Color fundus photograph:
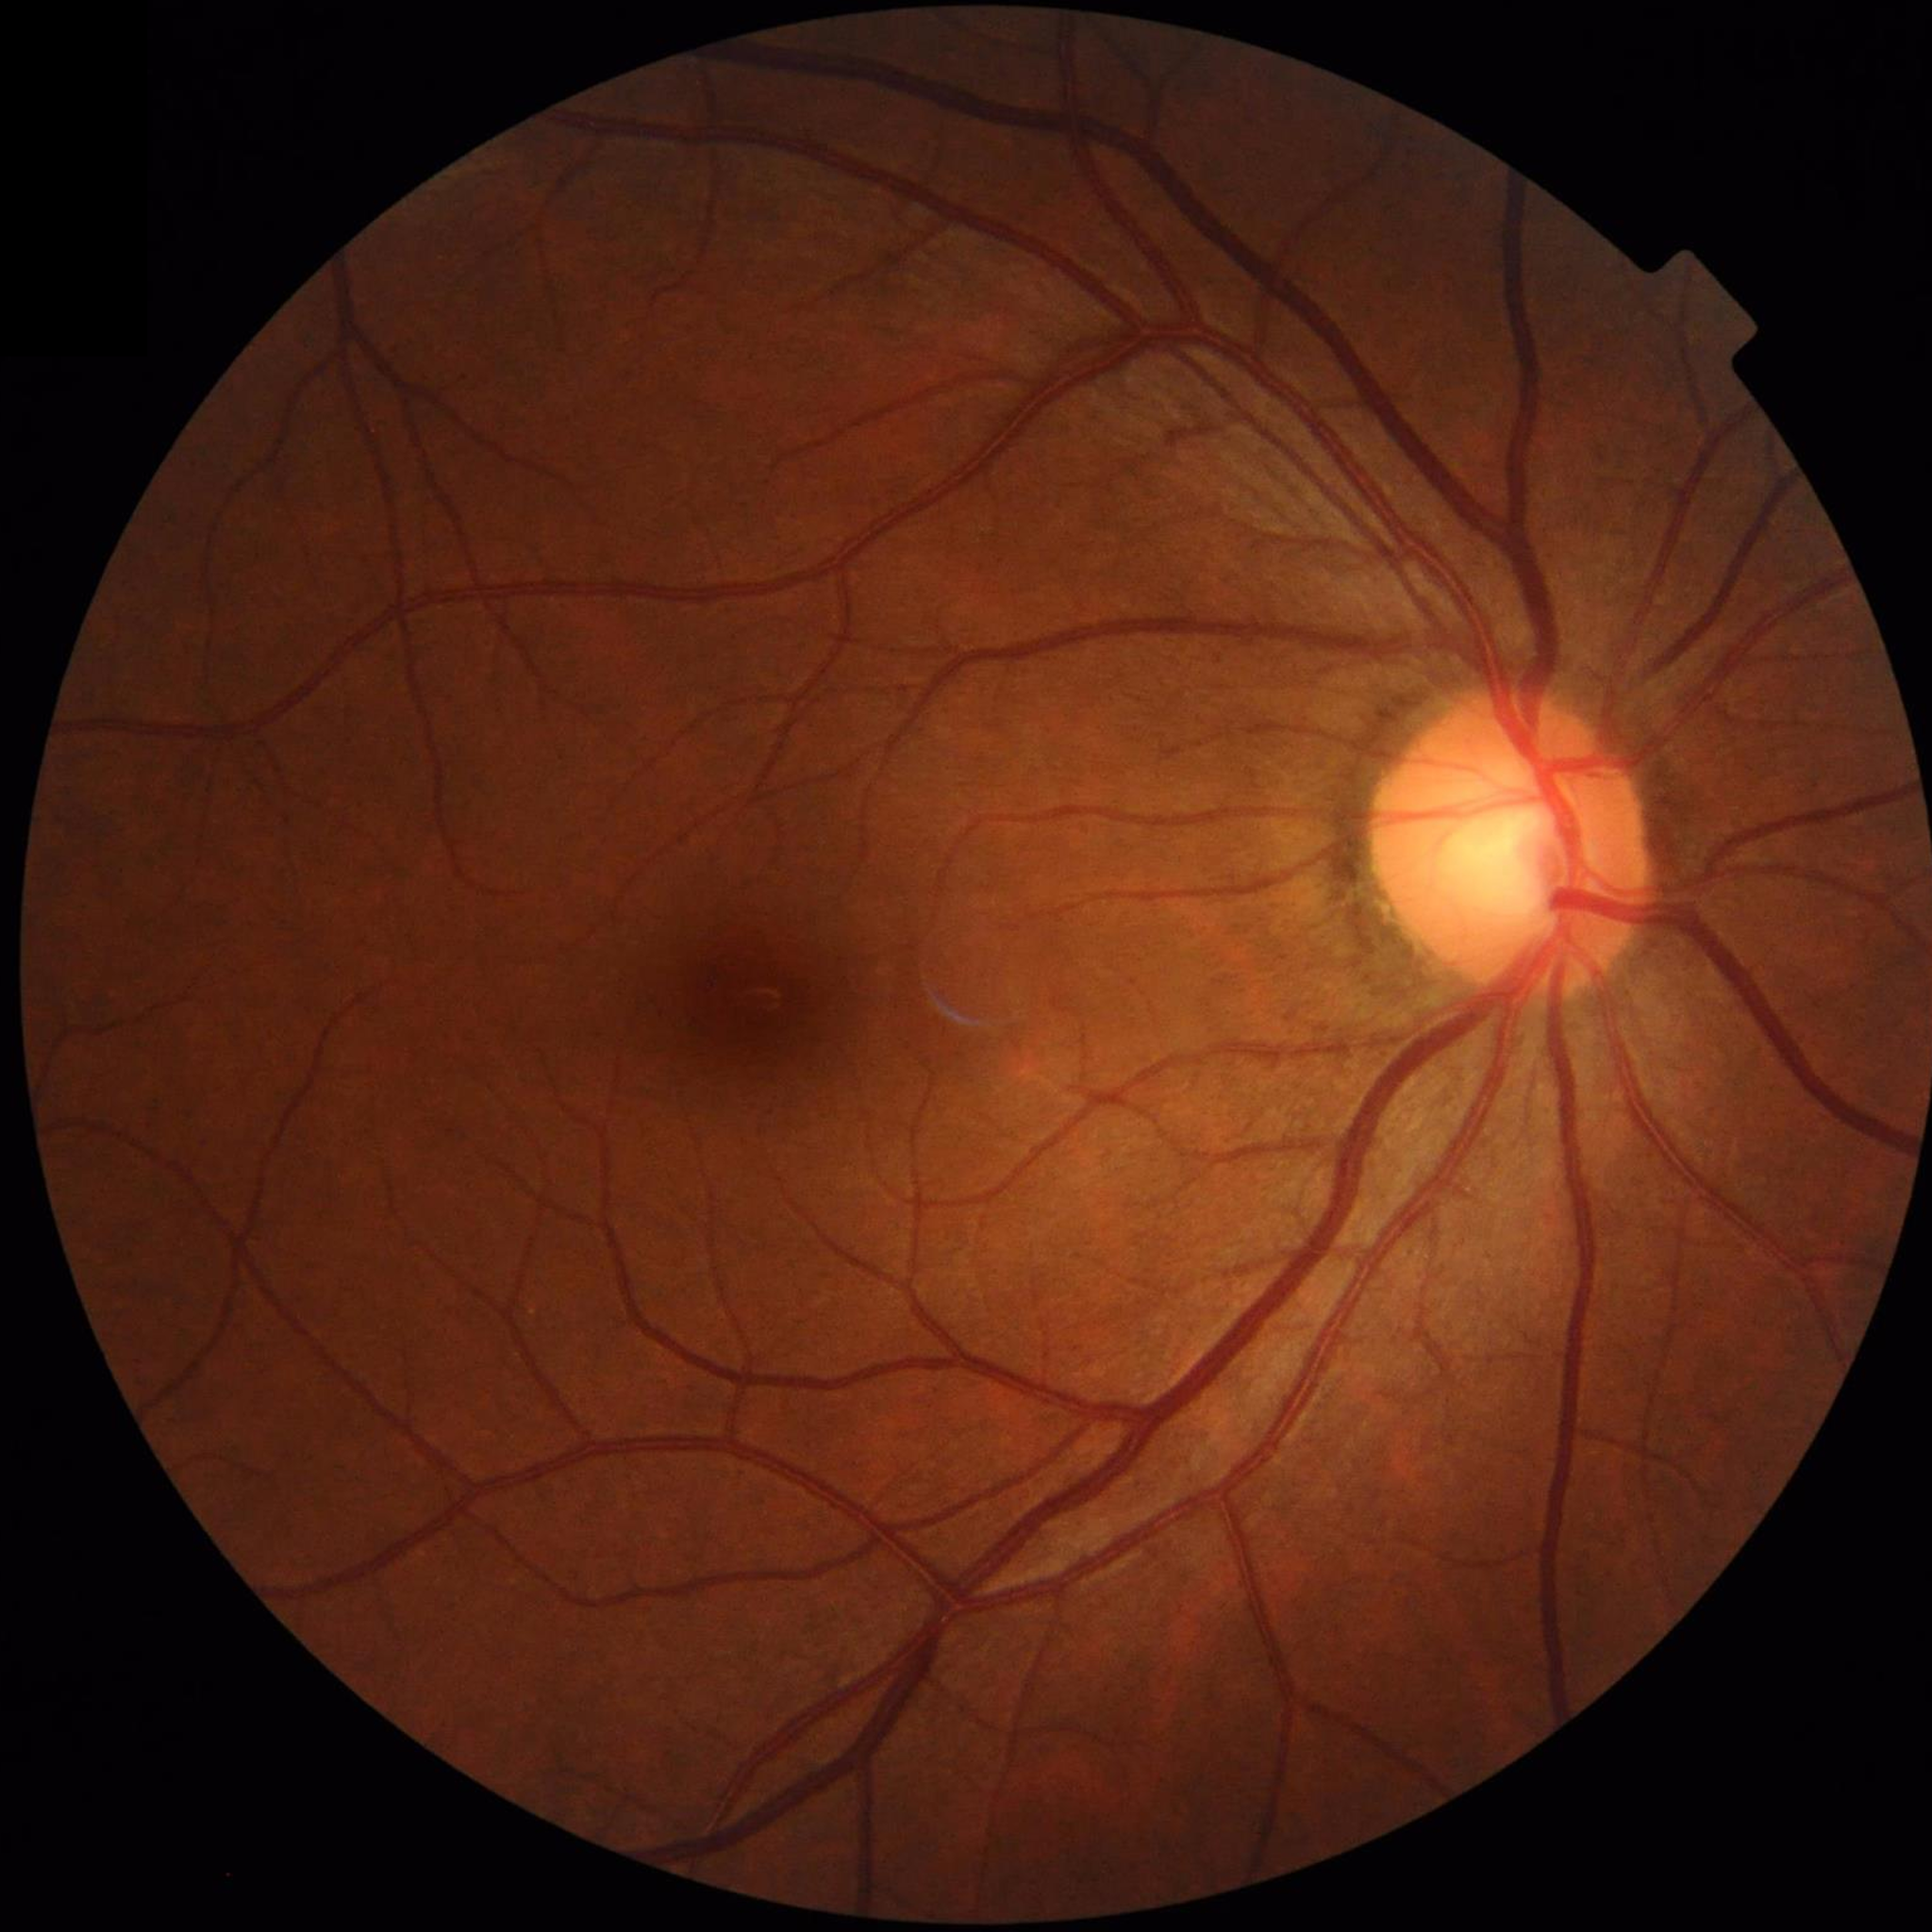 No AMD, DR, or glaucomatous findings.